Image size 1725x1721 · color fundus image · 45° FOV.
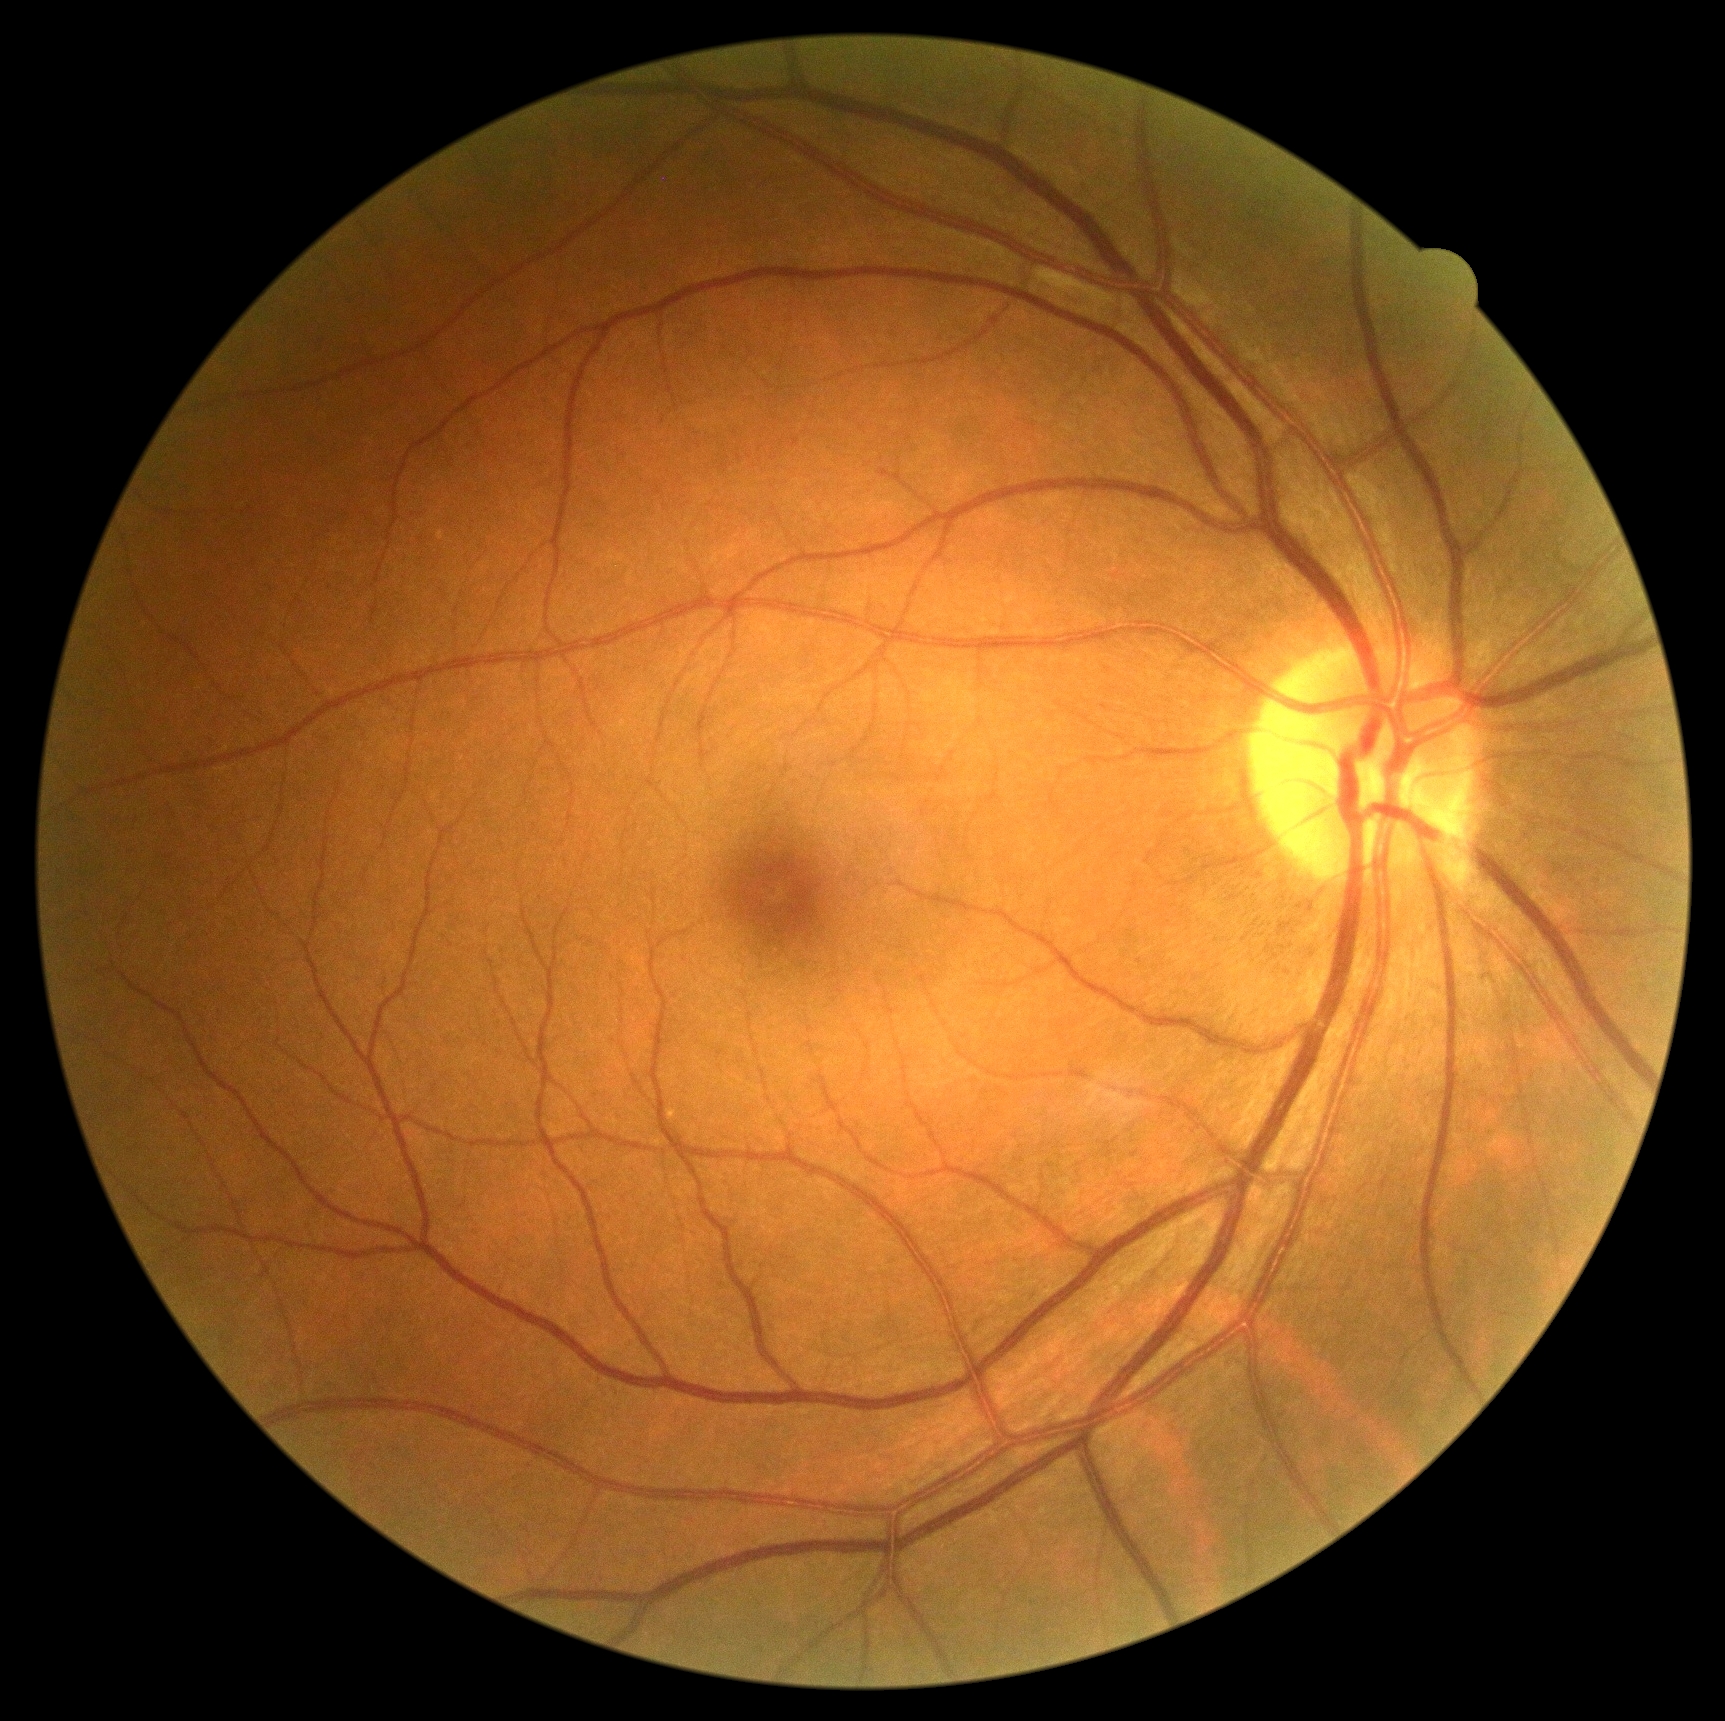 {"dr_grade": "no apparent retinopathy (grade 0)"}